RetCam wide-field infant fundus image; image size 1440x1080: 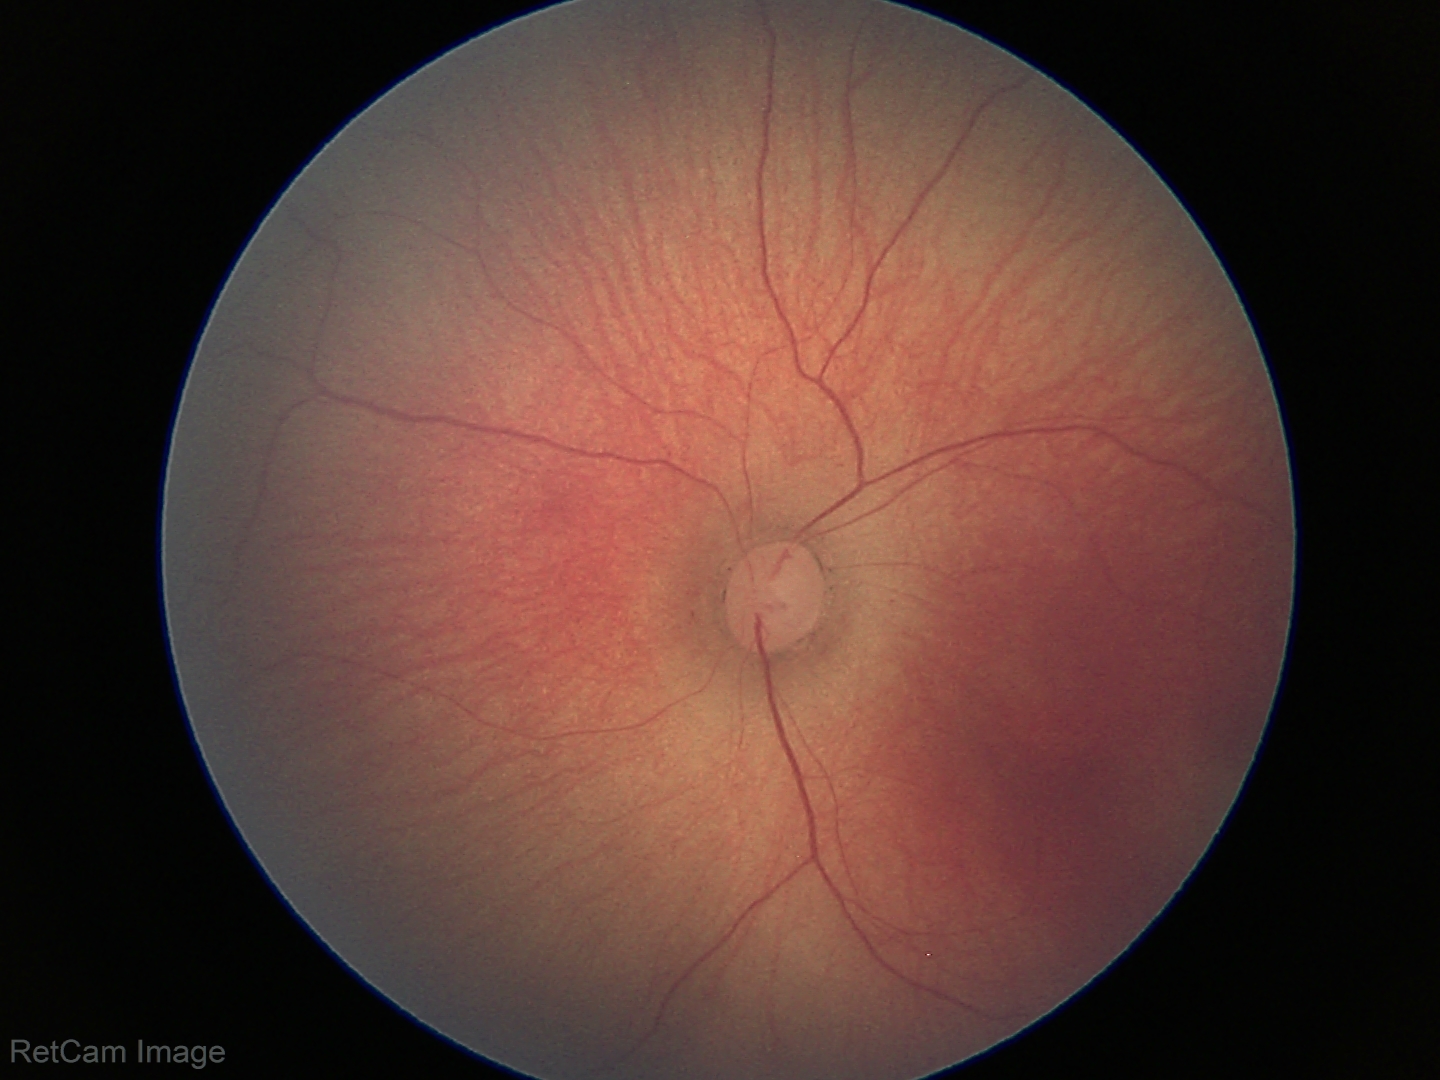 Diagnosis from this screening exam: ROP stage 1.